Retinal fundus photograph · NIDEK AFC-230 fundus camera · 848 x 848 pixels: 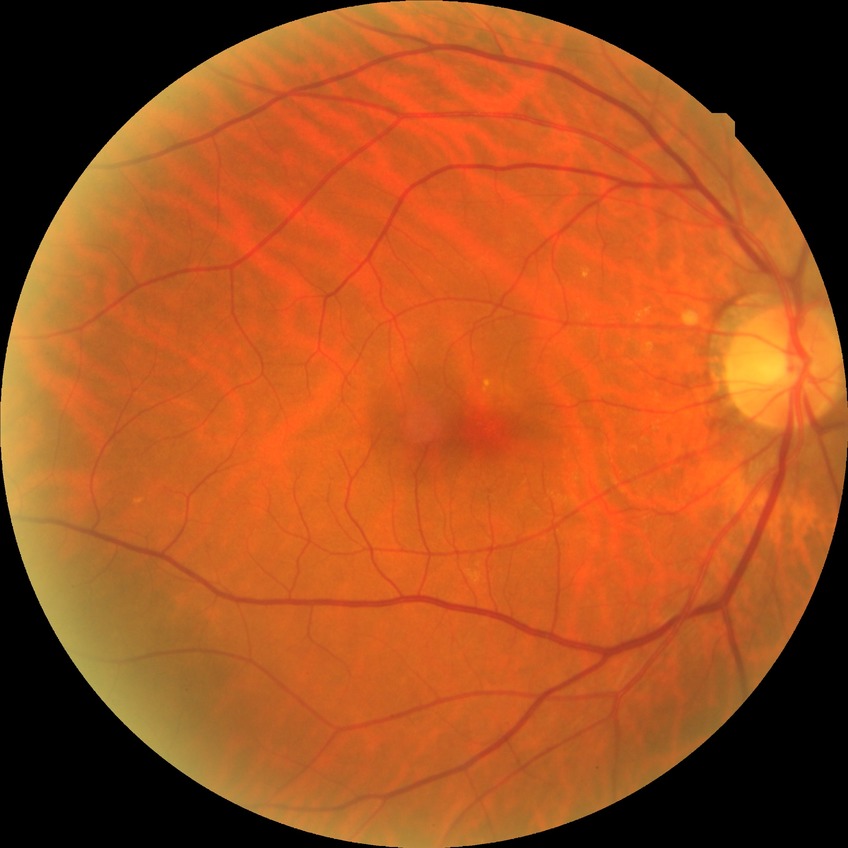

Davis grading is no diabetic retinopathy.